Camera: Remidio Fundus on Phone (FOP) camera:
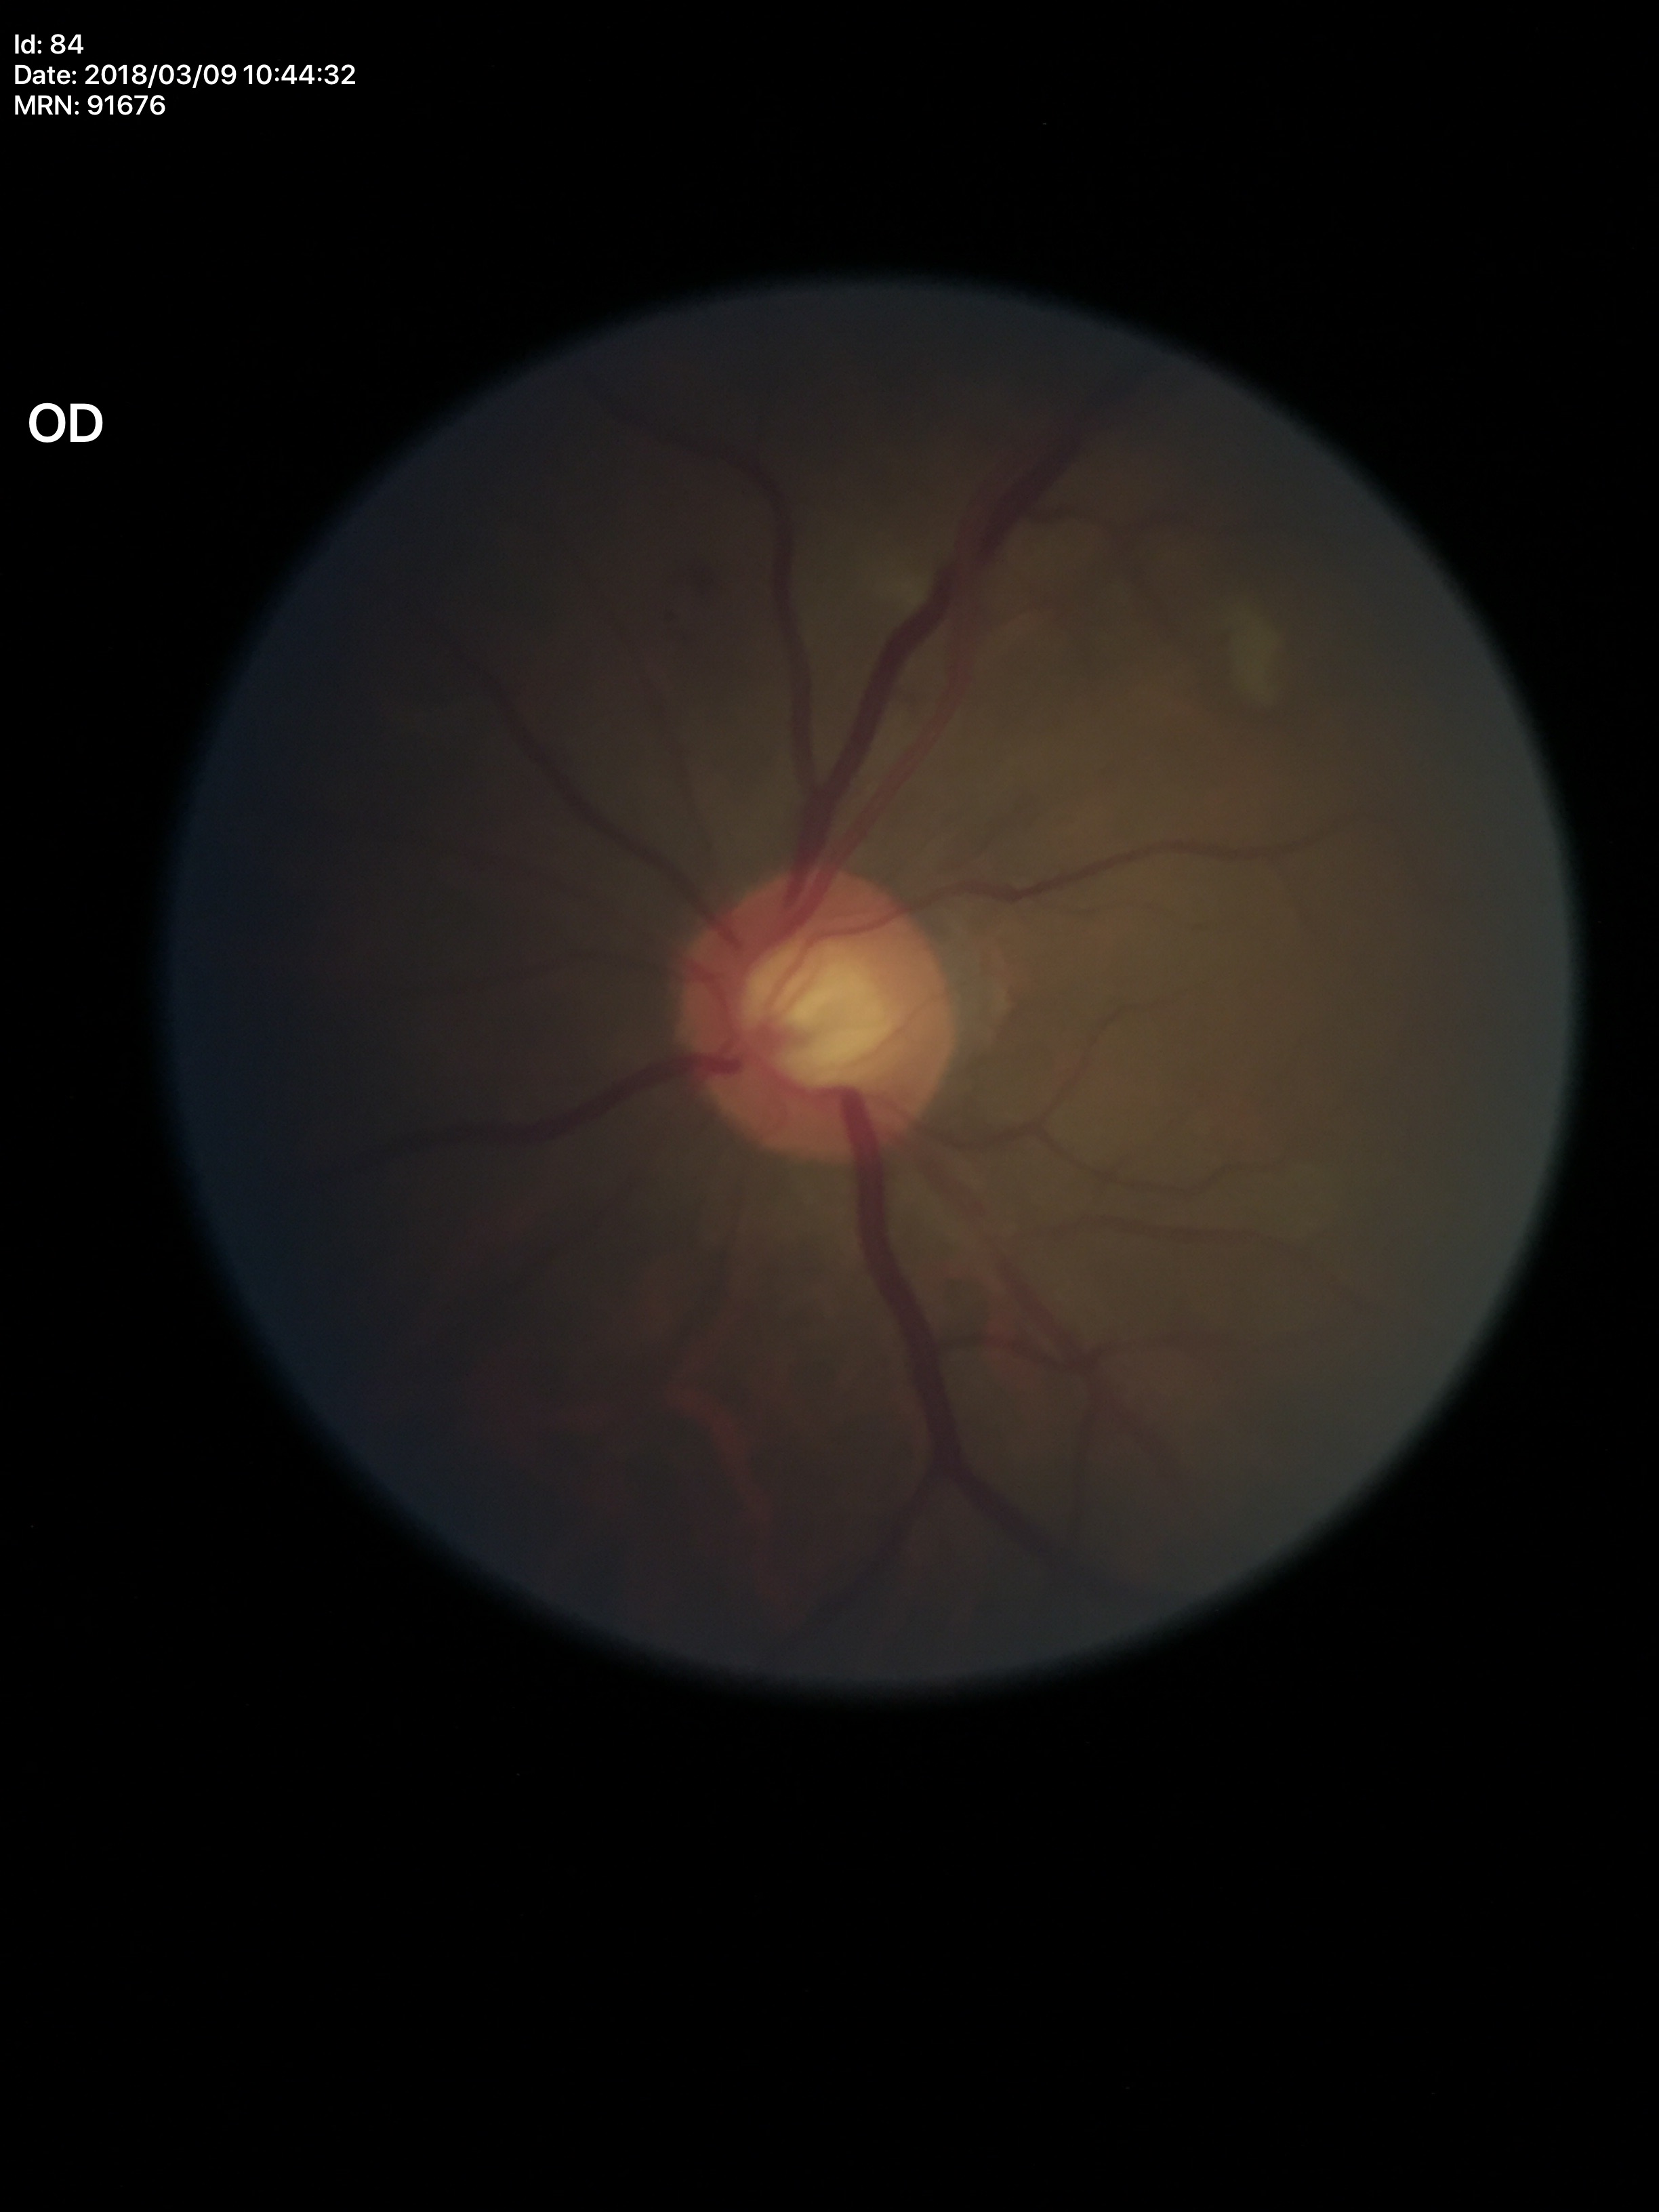

No signs of glaucoma. Vertical cup-to-disc ratio (VCDR): 0.57.